CFP, 2048x1536:
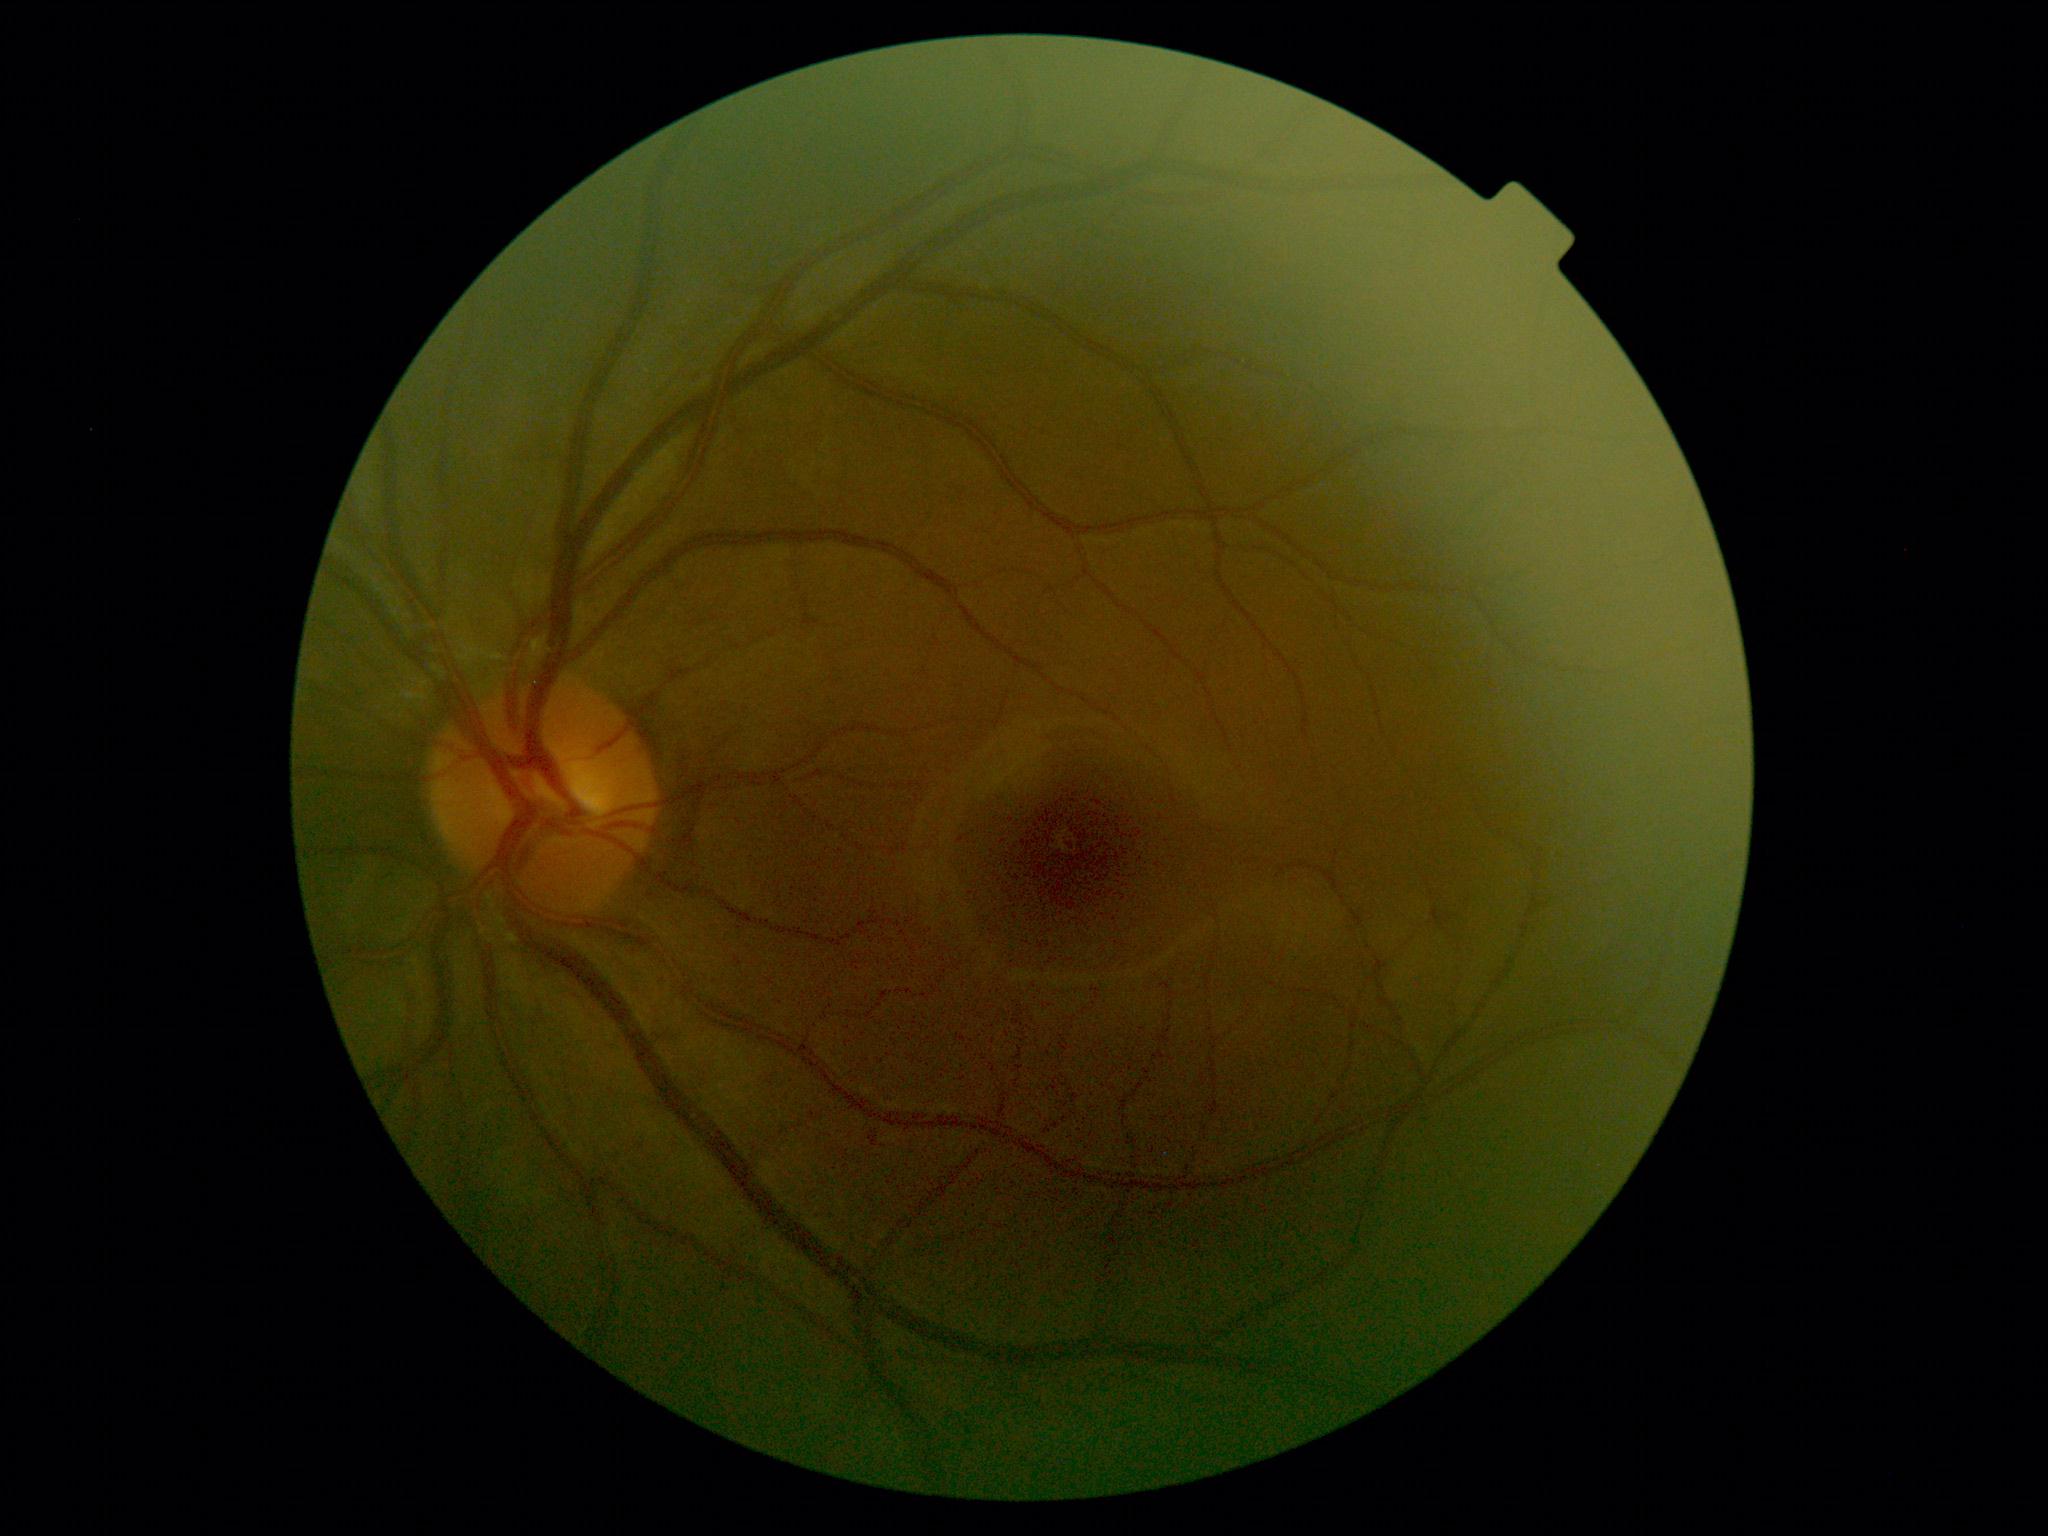
• DR — grade 0